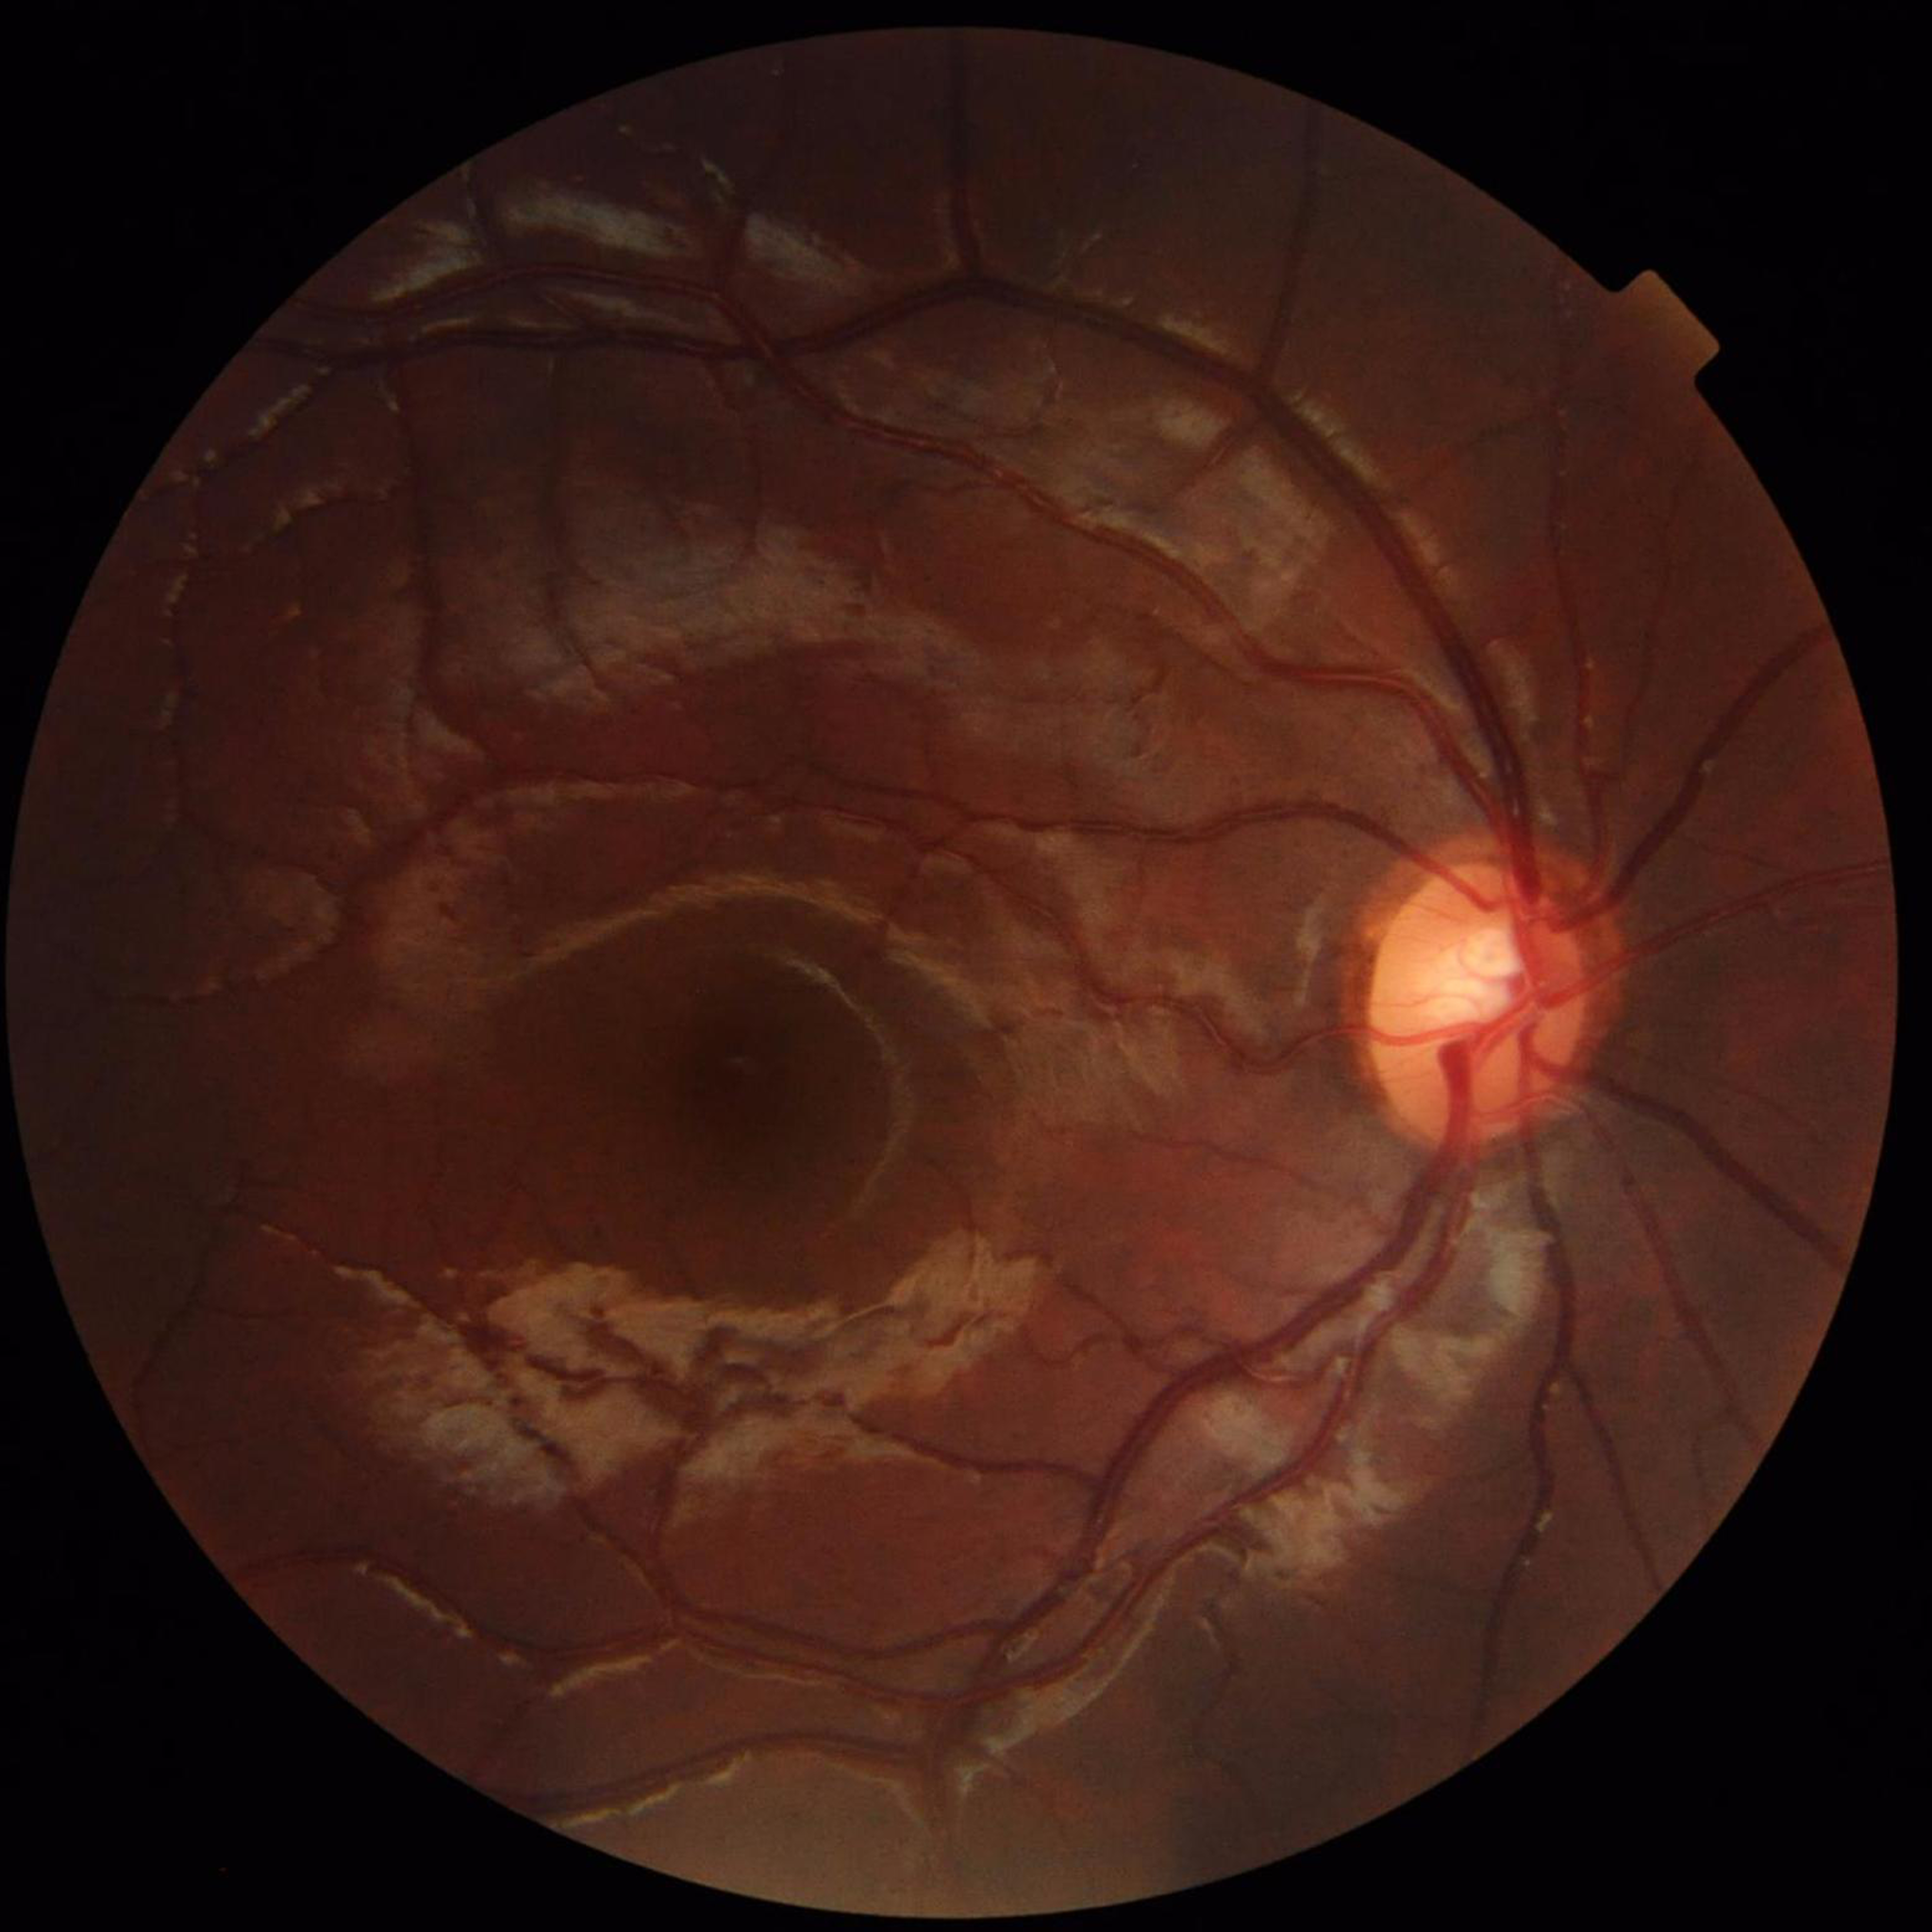 Quality assessment: no blur, contrast adequate, illumination and color satisfactory. Color fundus photograph with no signs of AMD, diabetic retinopathy, or glaucoma.